Retinal fundus photograph: 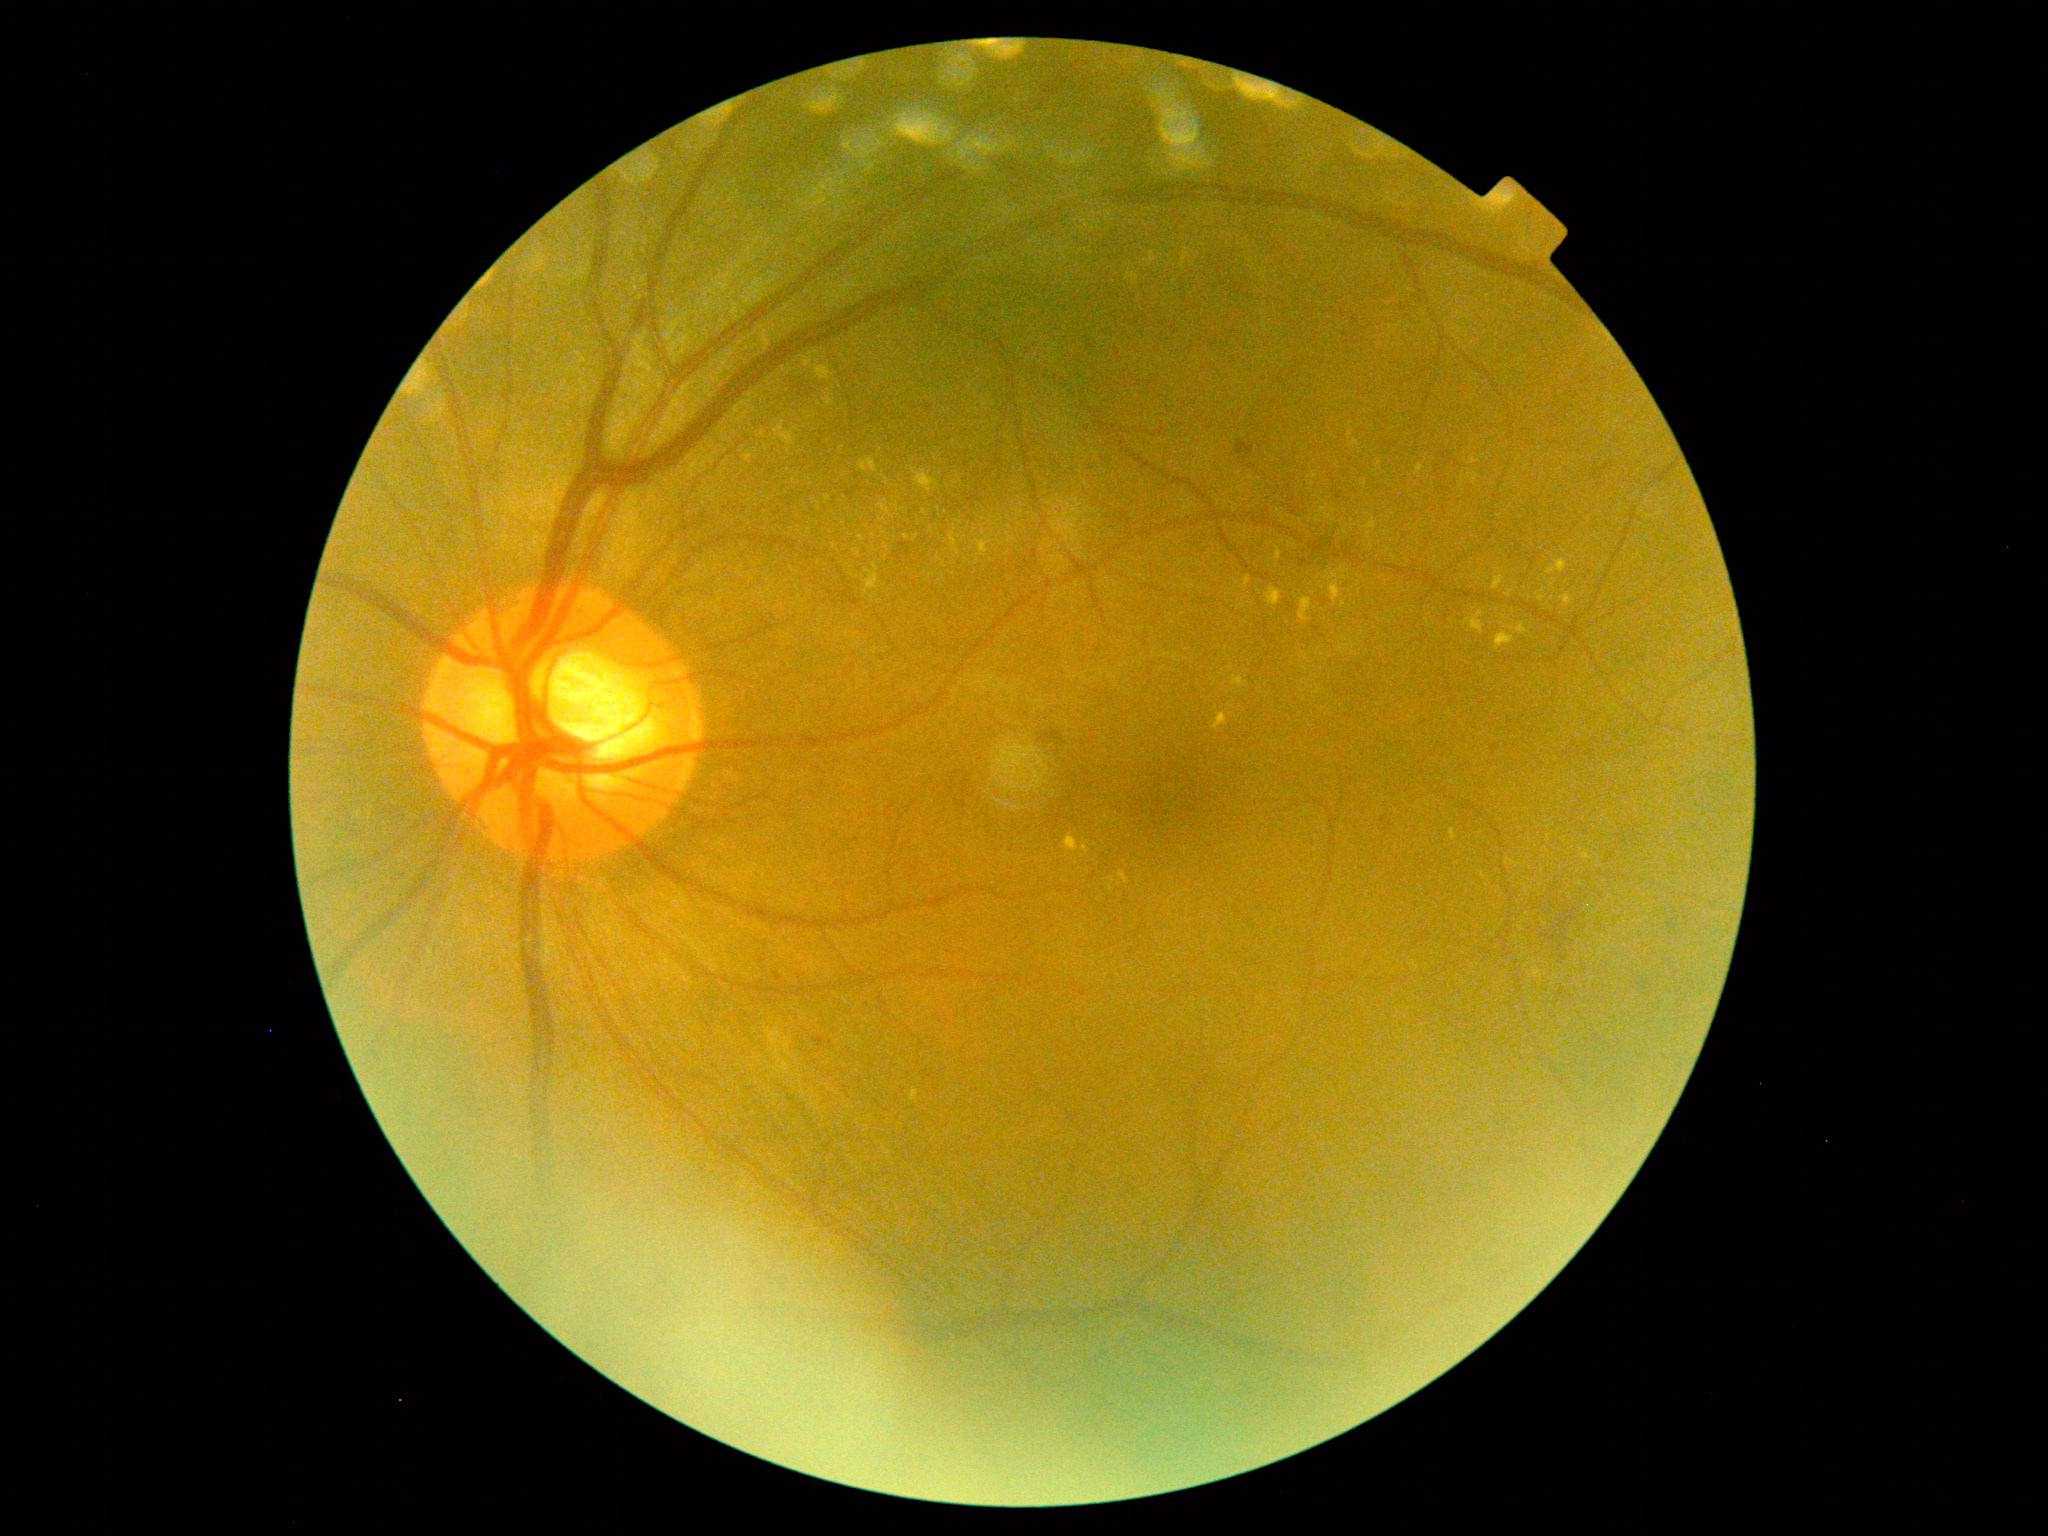
Diabetic retinopathy (DR): grade 2 (moderate NPDR) — more than just microaneurysms but less than severe NPDR.